Captured after pupil dilation · 1932 x 1932 pixels — 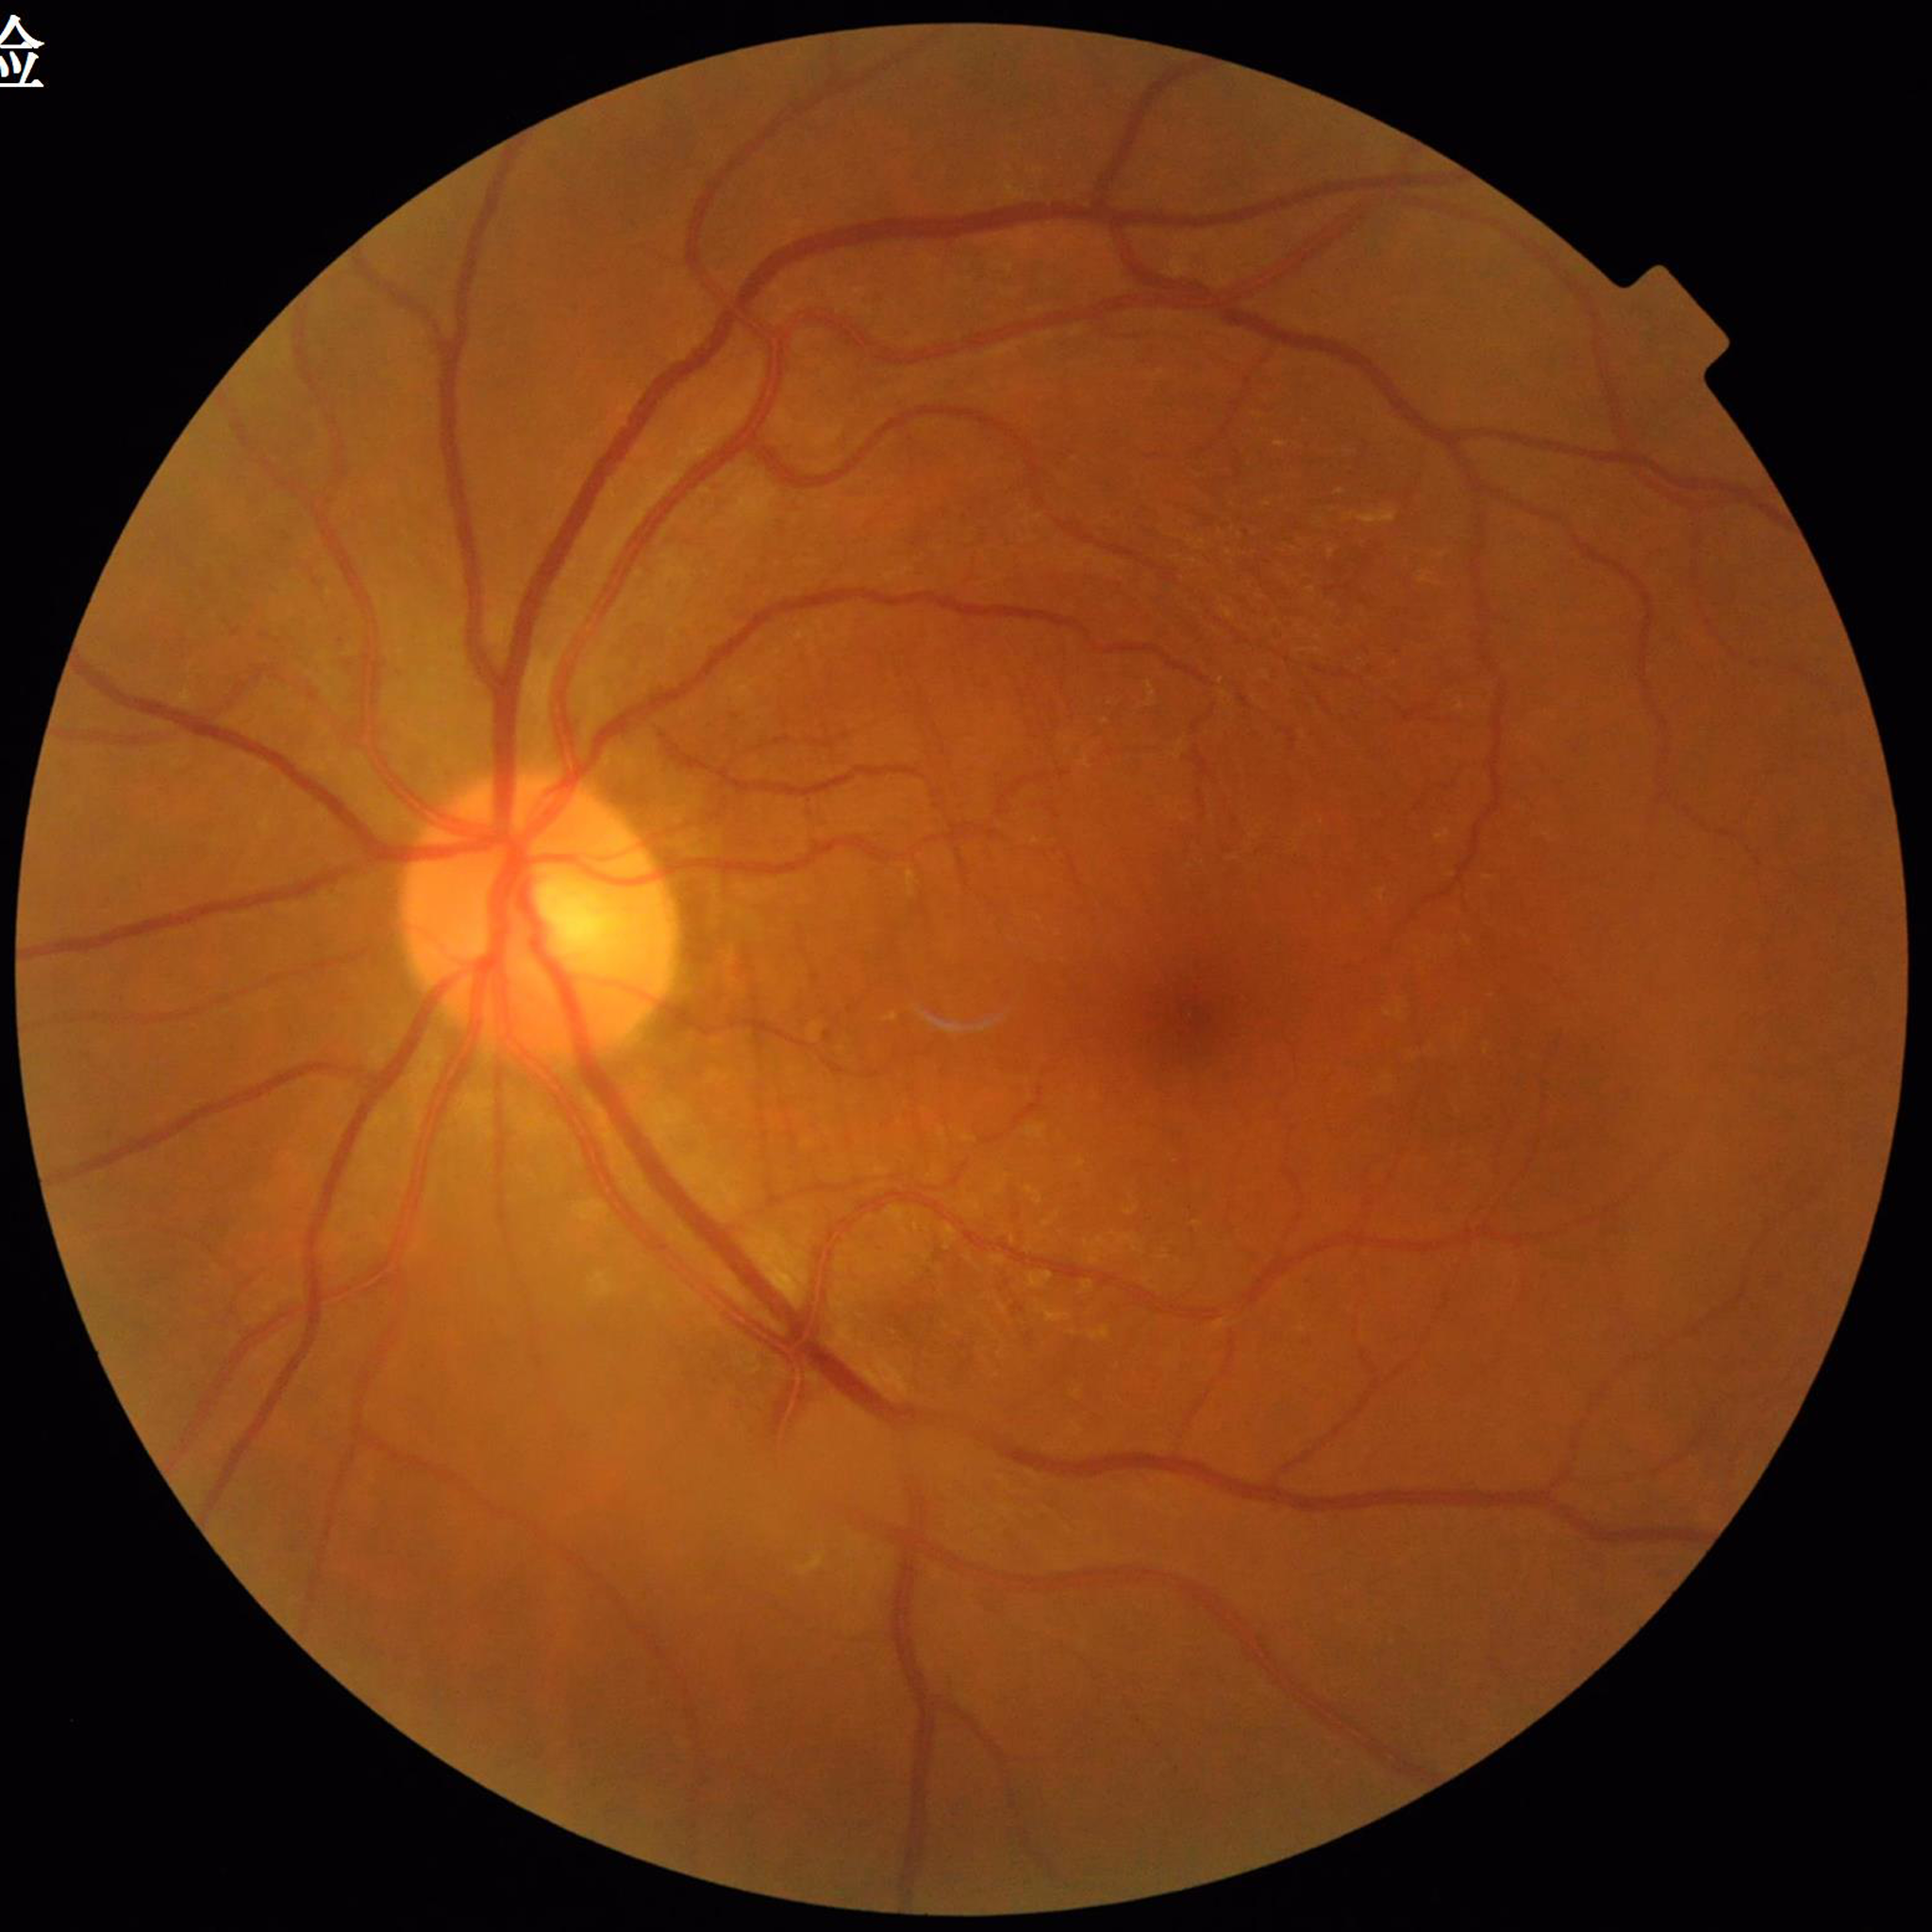

Diagnosed with DR.